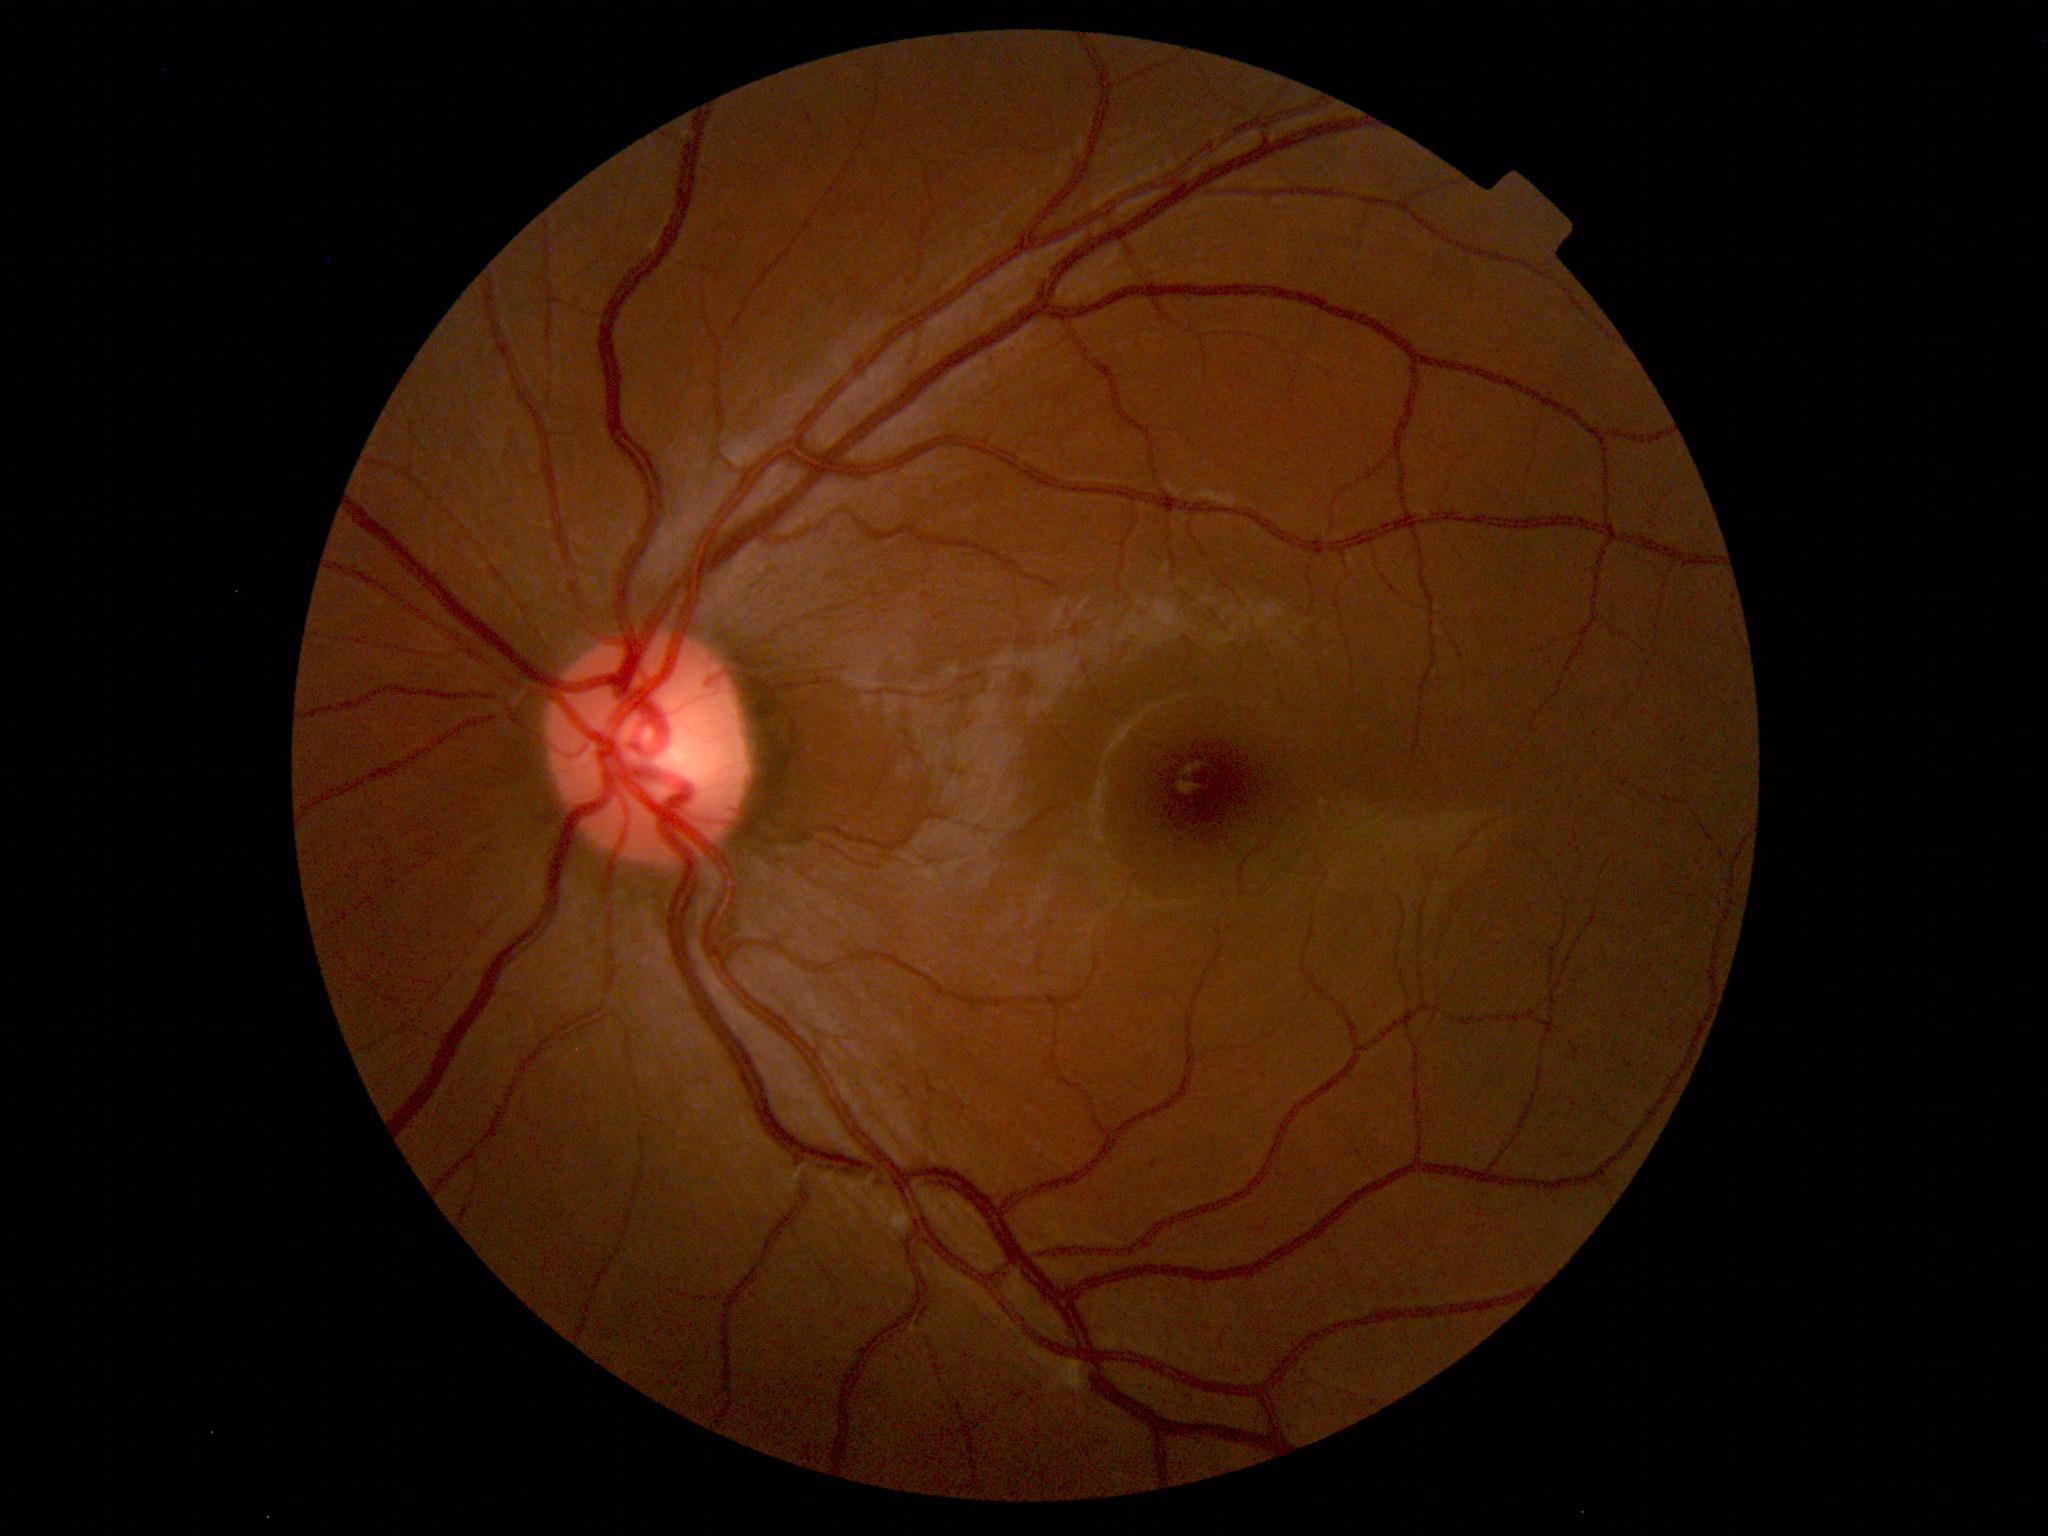
Findings: no abnormalities.